848 by 848 pixels — 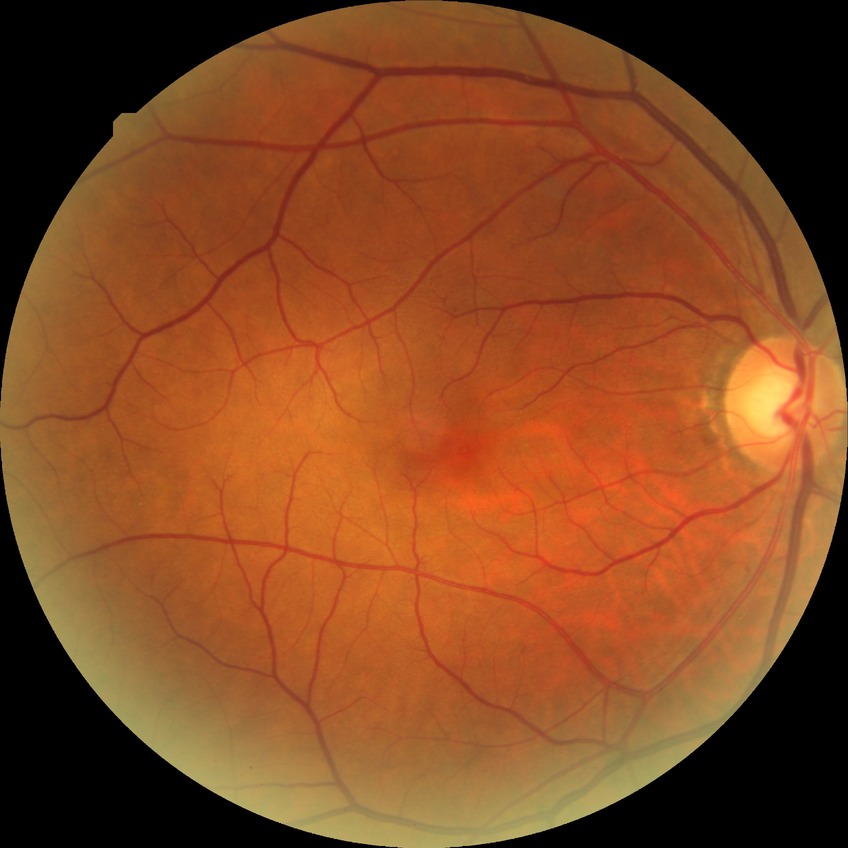
Annotations:
* diabetic retinopathy (DR) — no diabetic retinopathy (NDR)